Davis DR grading — 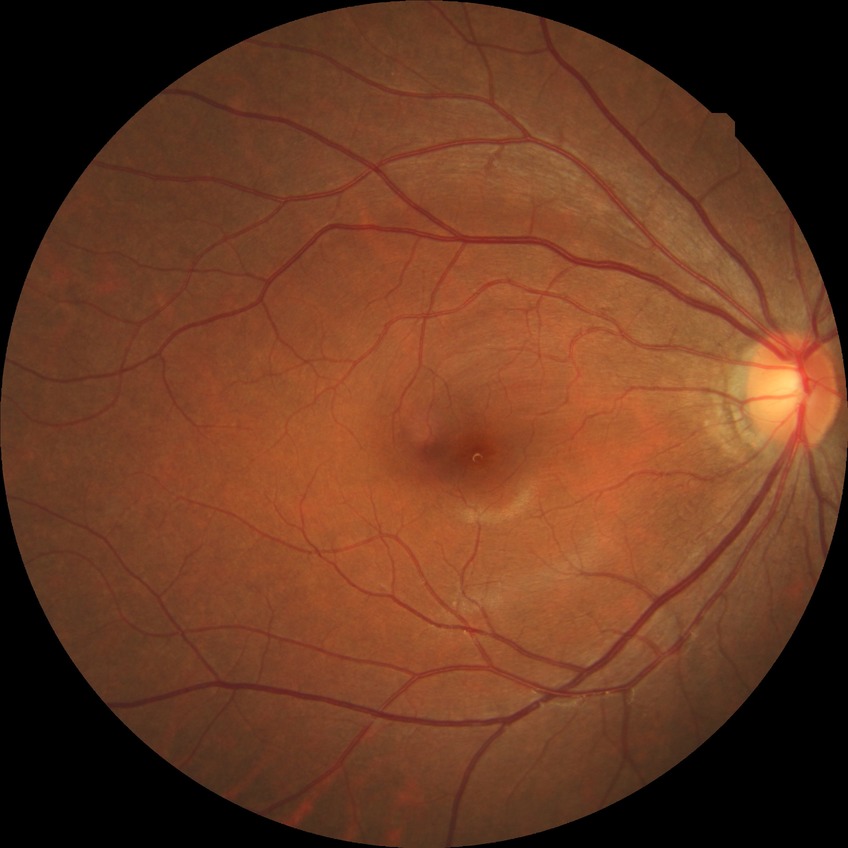

Diabetic retinopathy (DR) is no diabetic retinopathy (NDR).